Fundus photo, 2212 x 1659 pixels: 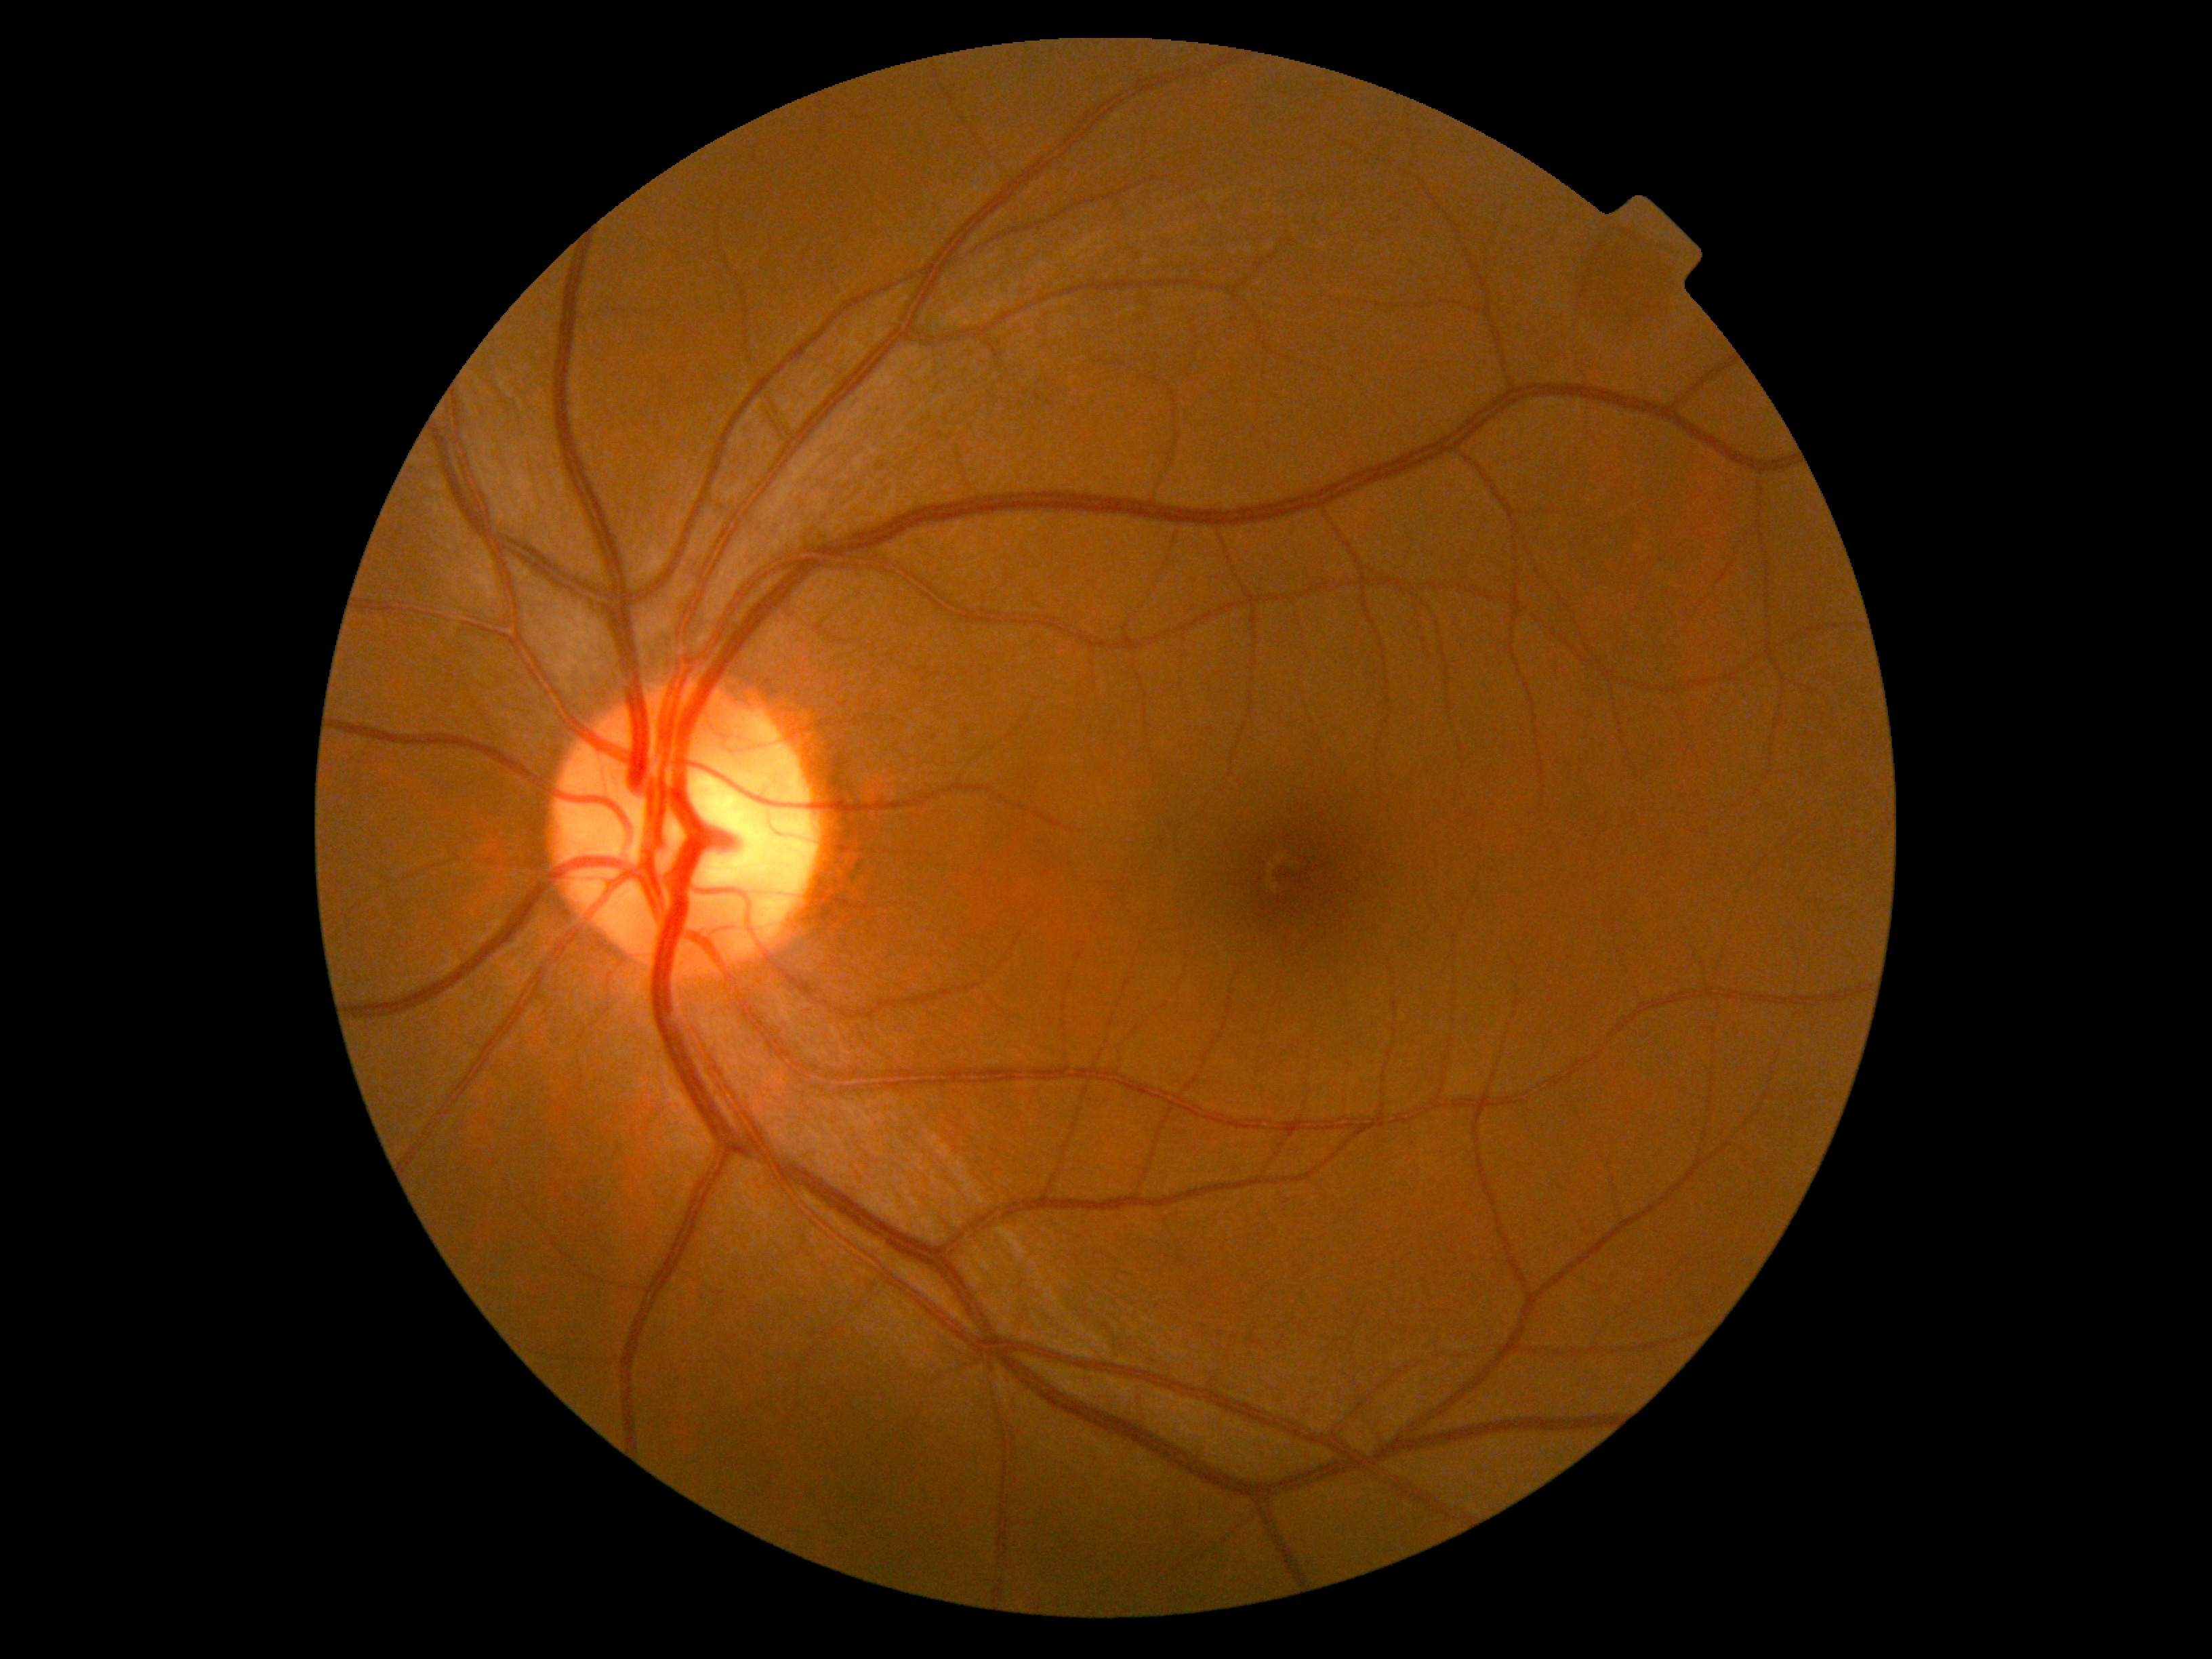
Retinopathy grade: 0 (no apparent retinopathy).